Davis DR grading · camera: NIDEK AFC-230:
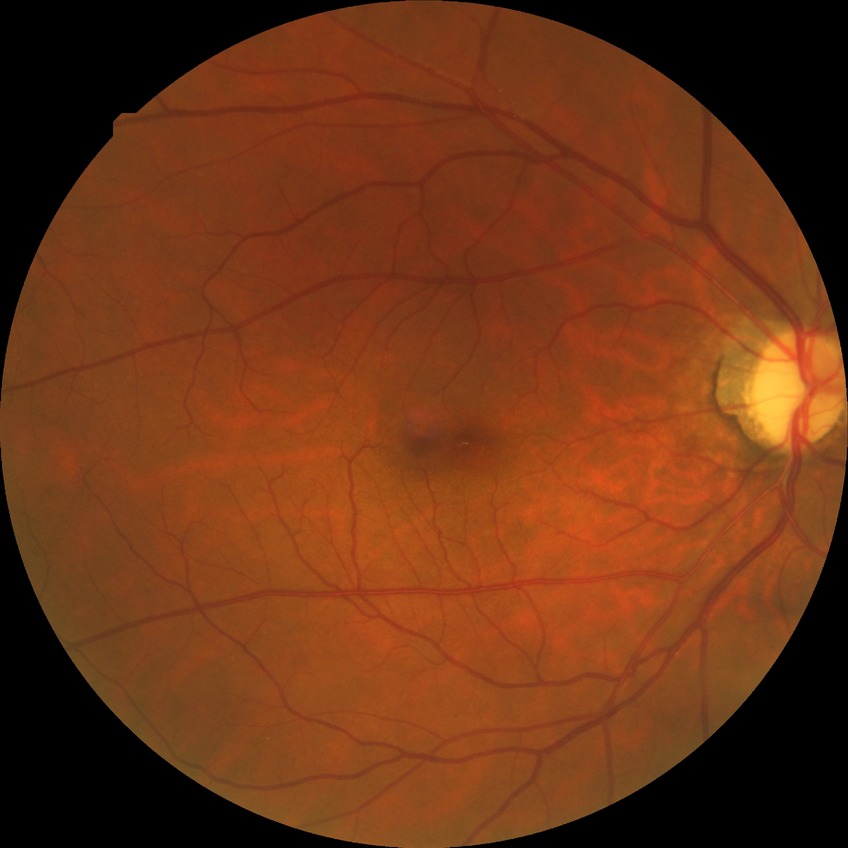 Assessment:
• diabetic retinopathy severity: simple diabetic retinopathy